45-degree field of view:
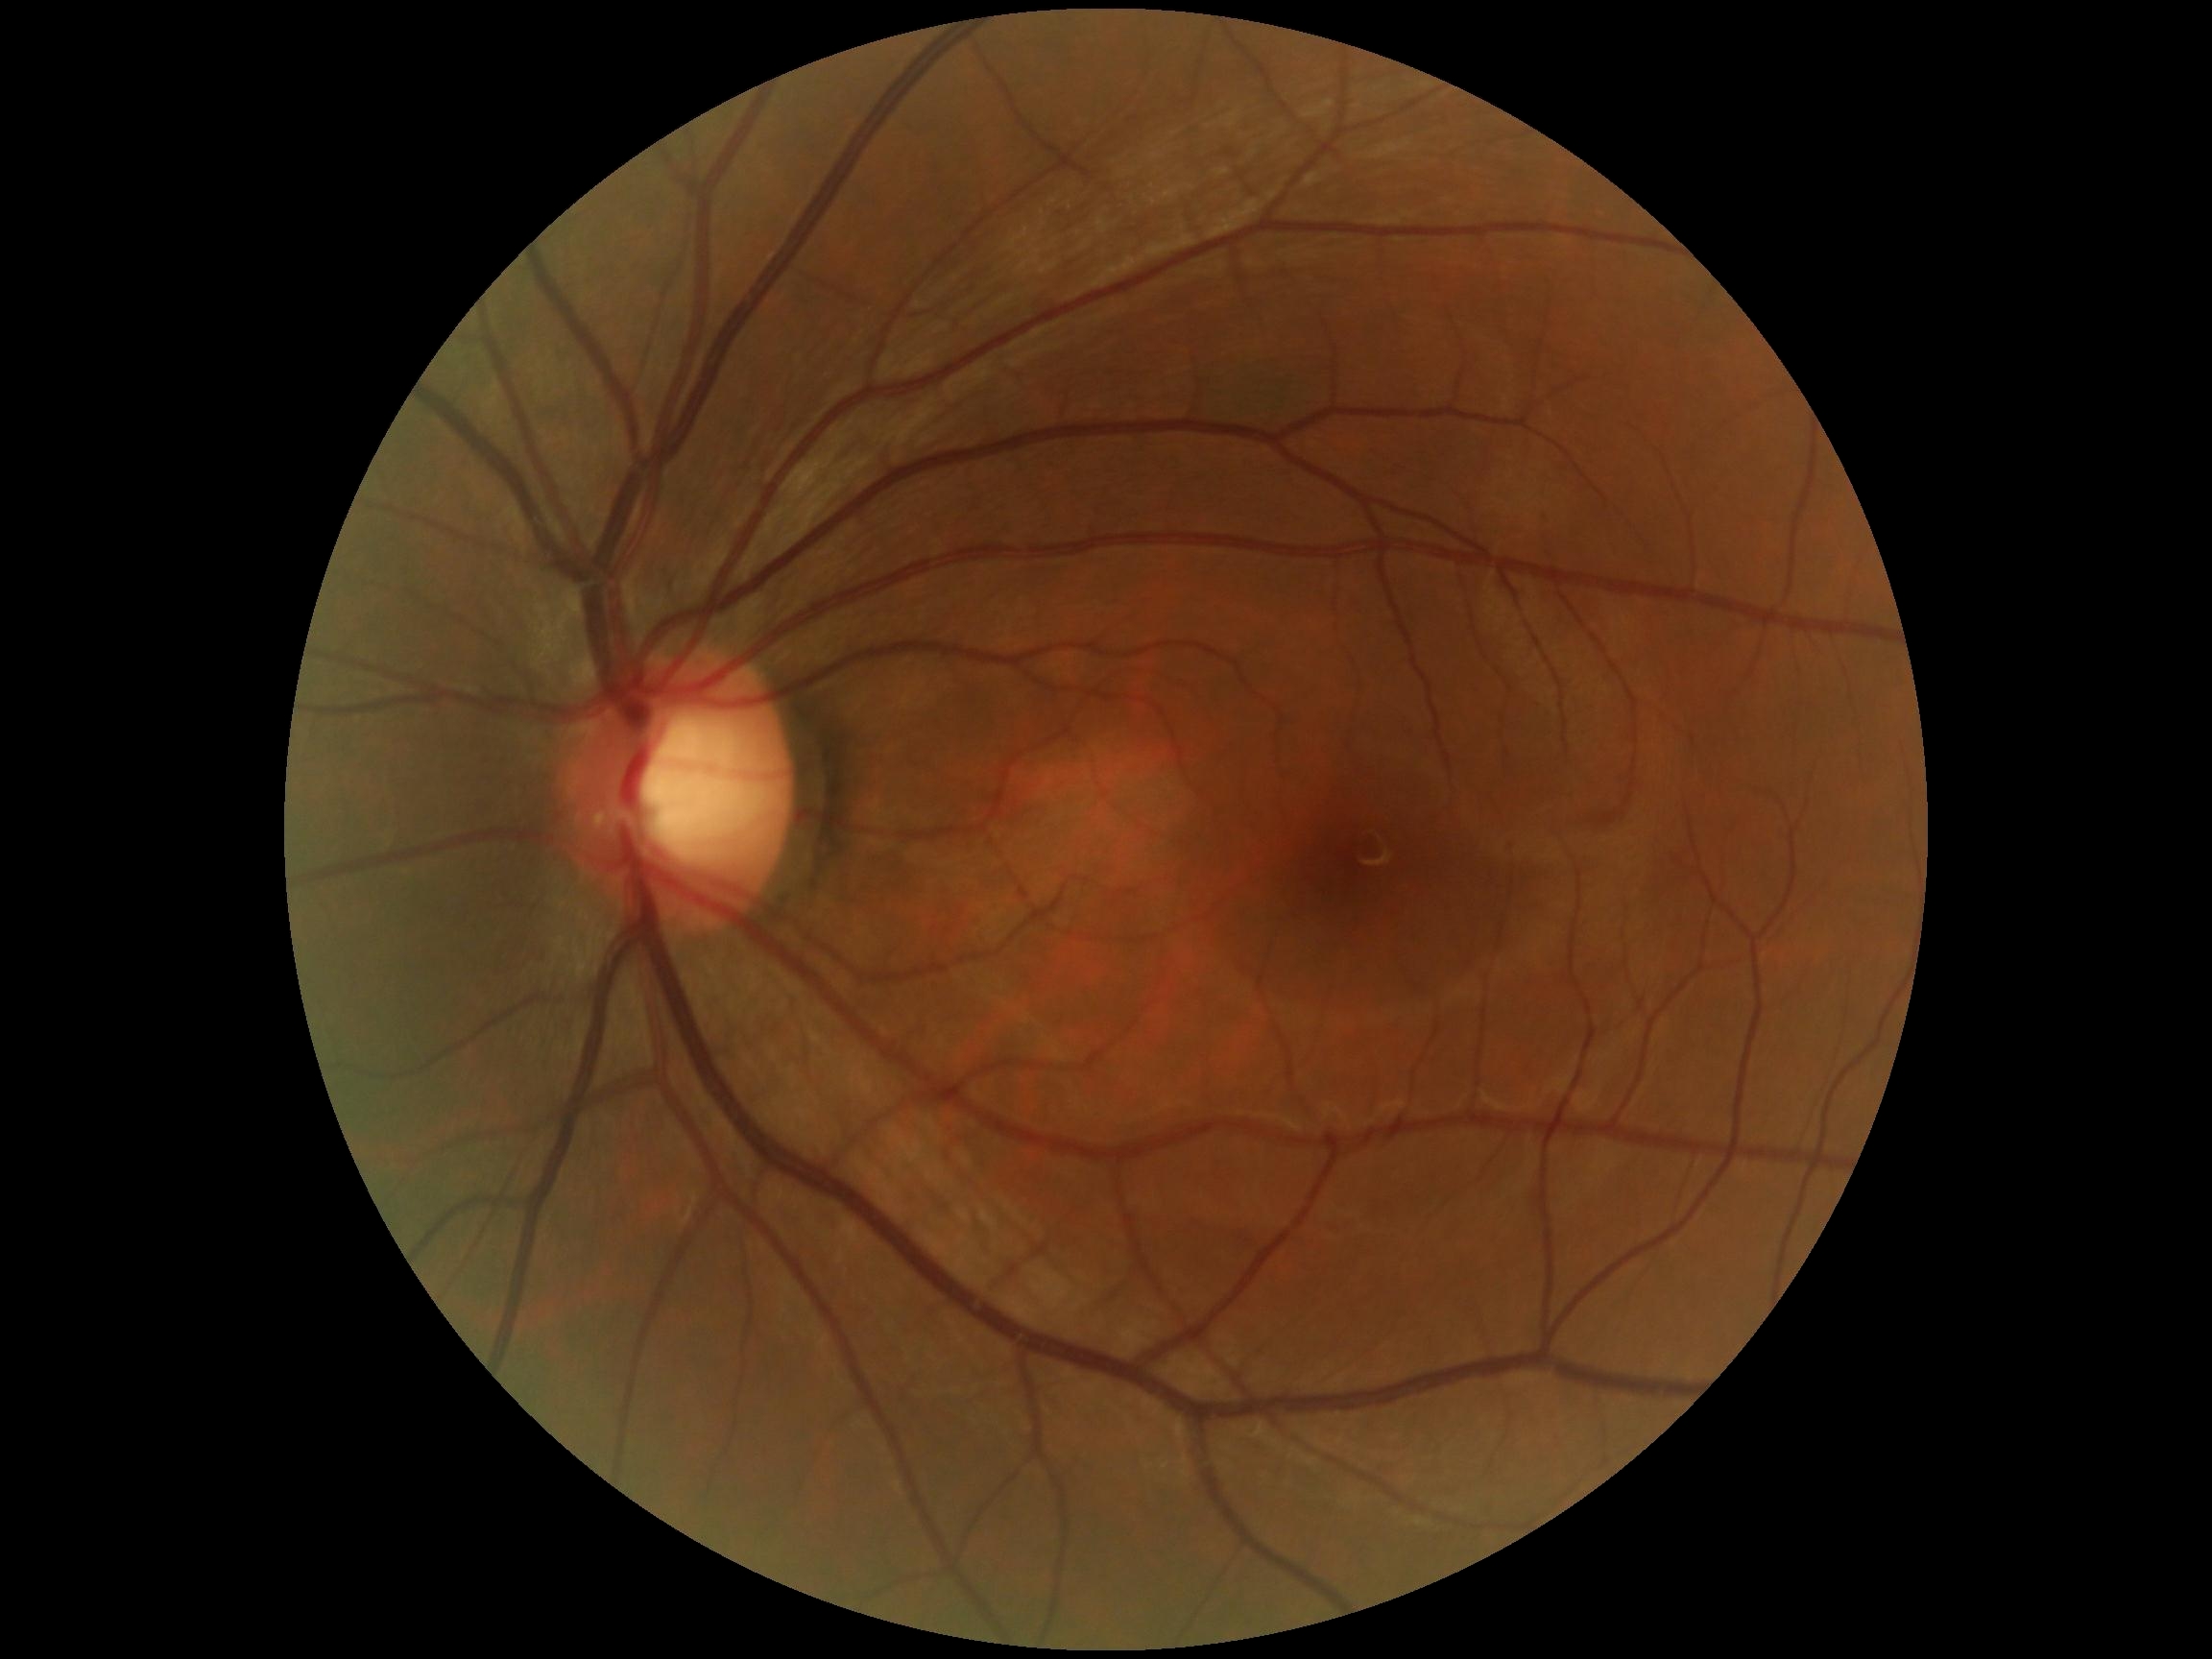 Diabetic retinopathy (DR): grade 0 (no apparent retinopathy).
No signs of diabetic retinopathy.